Posterior pole photograph. 45 degree fundus photograph: 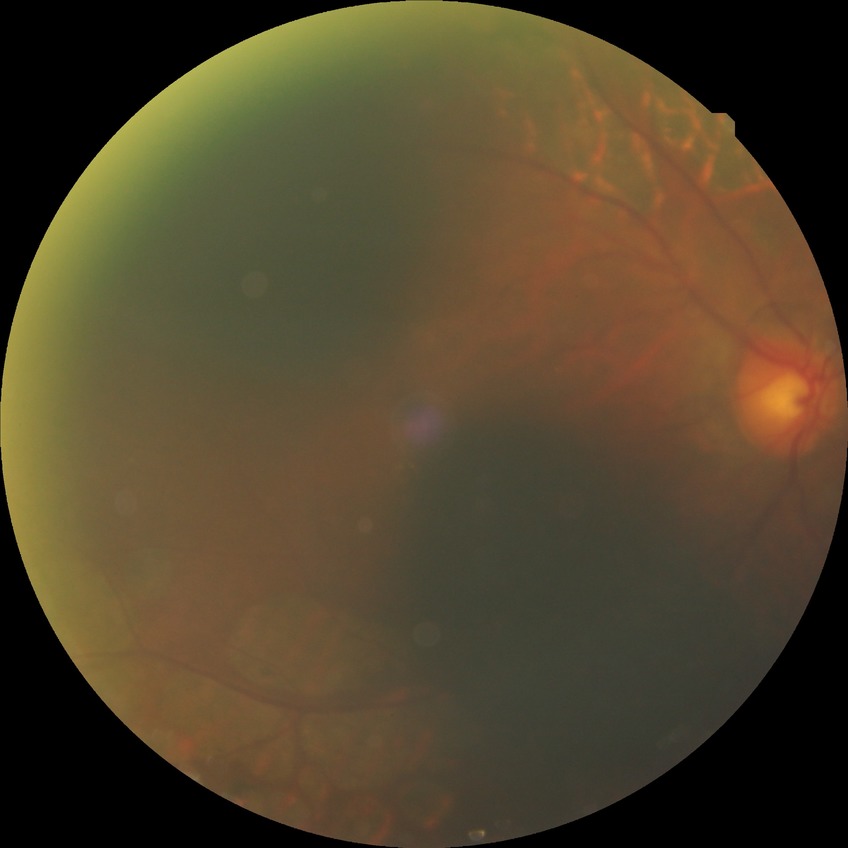
Diabetic retinopathy (DR): proliferative diabetic retinopathy (PDR).